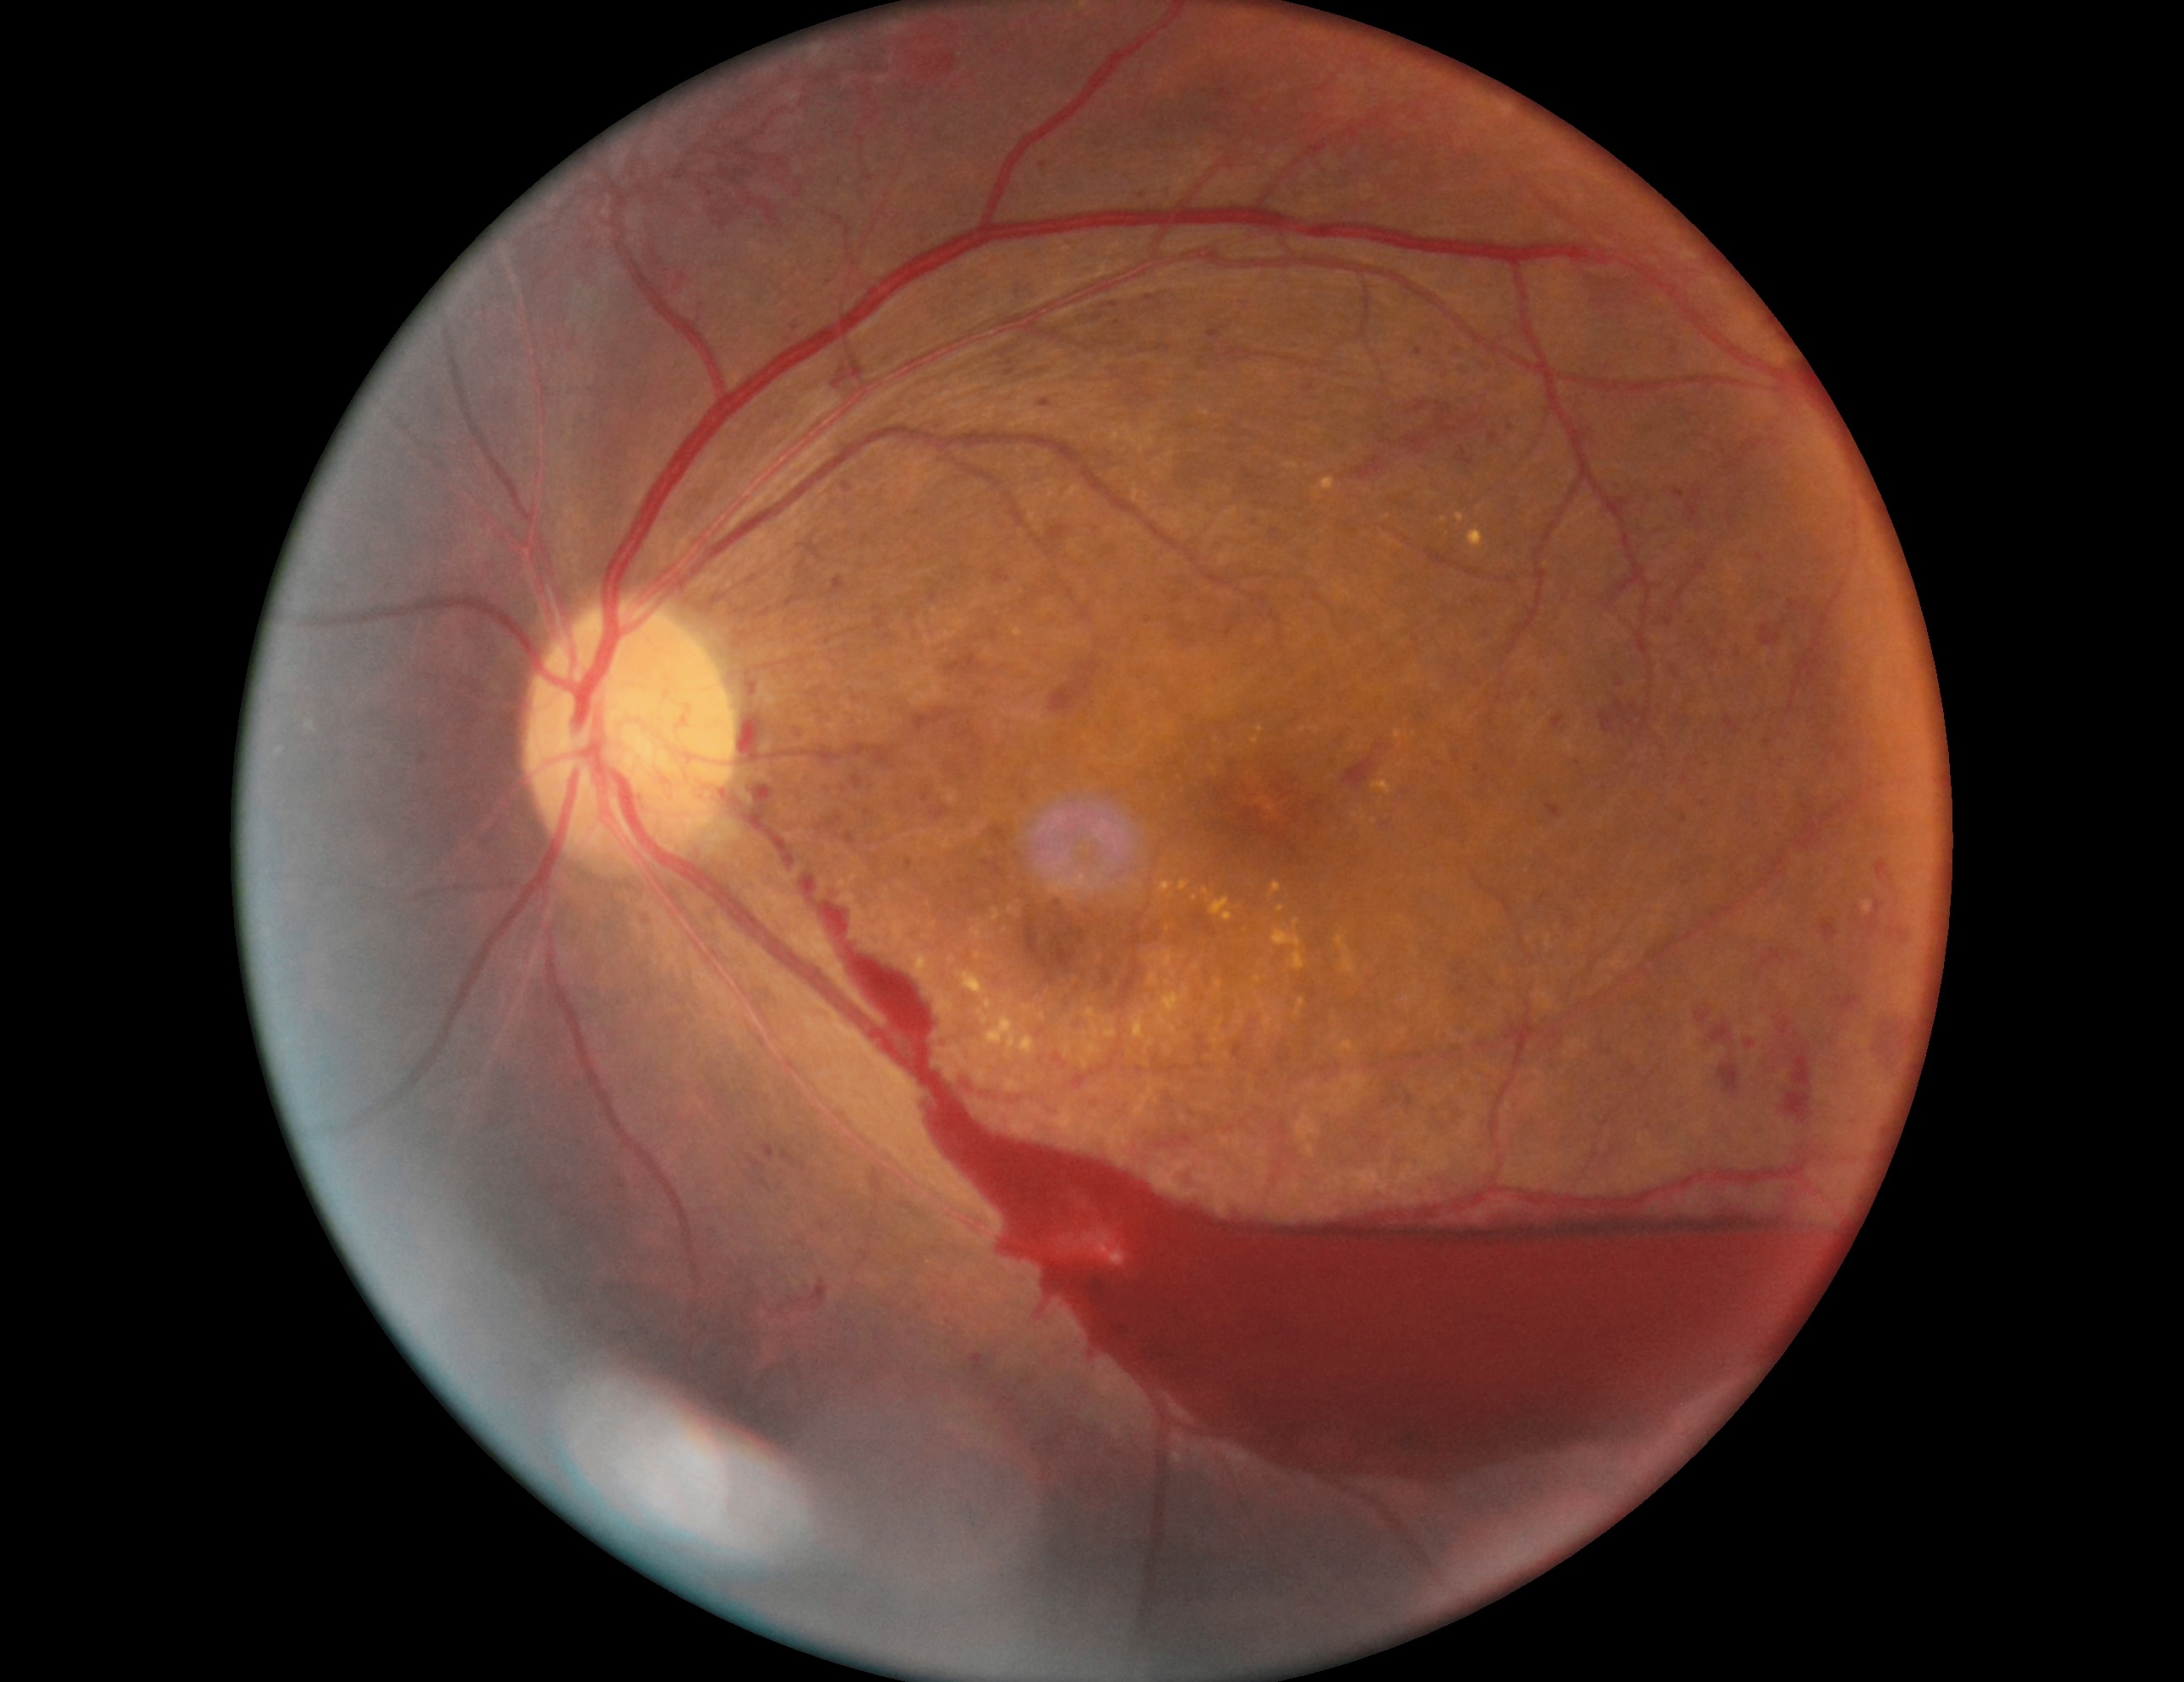
dr_grade: 4
dr_category: proliferative diabetic retinopathy